2212 by 1659 pixels; 45° field of view — 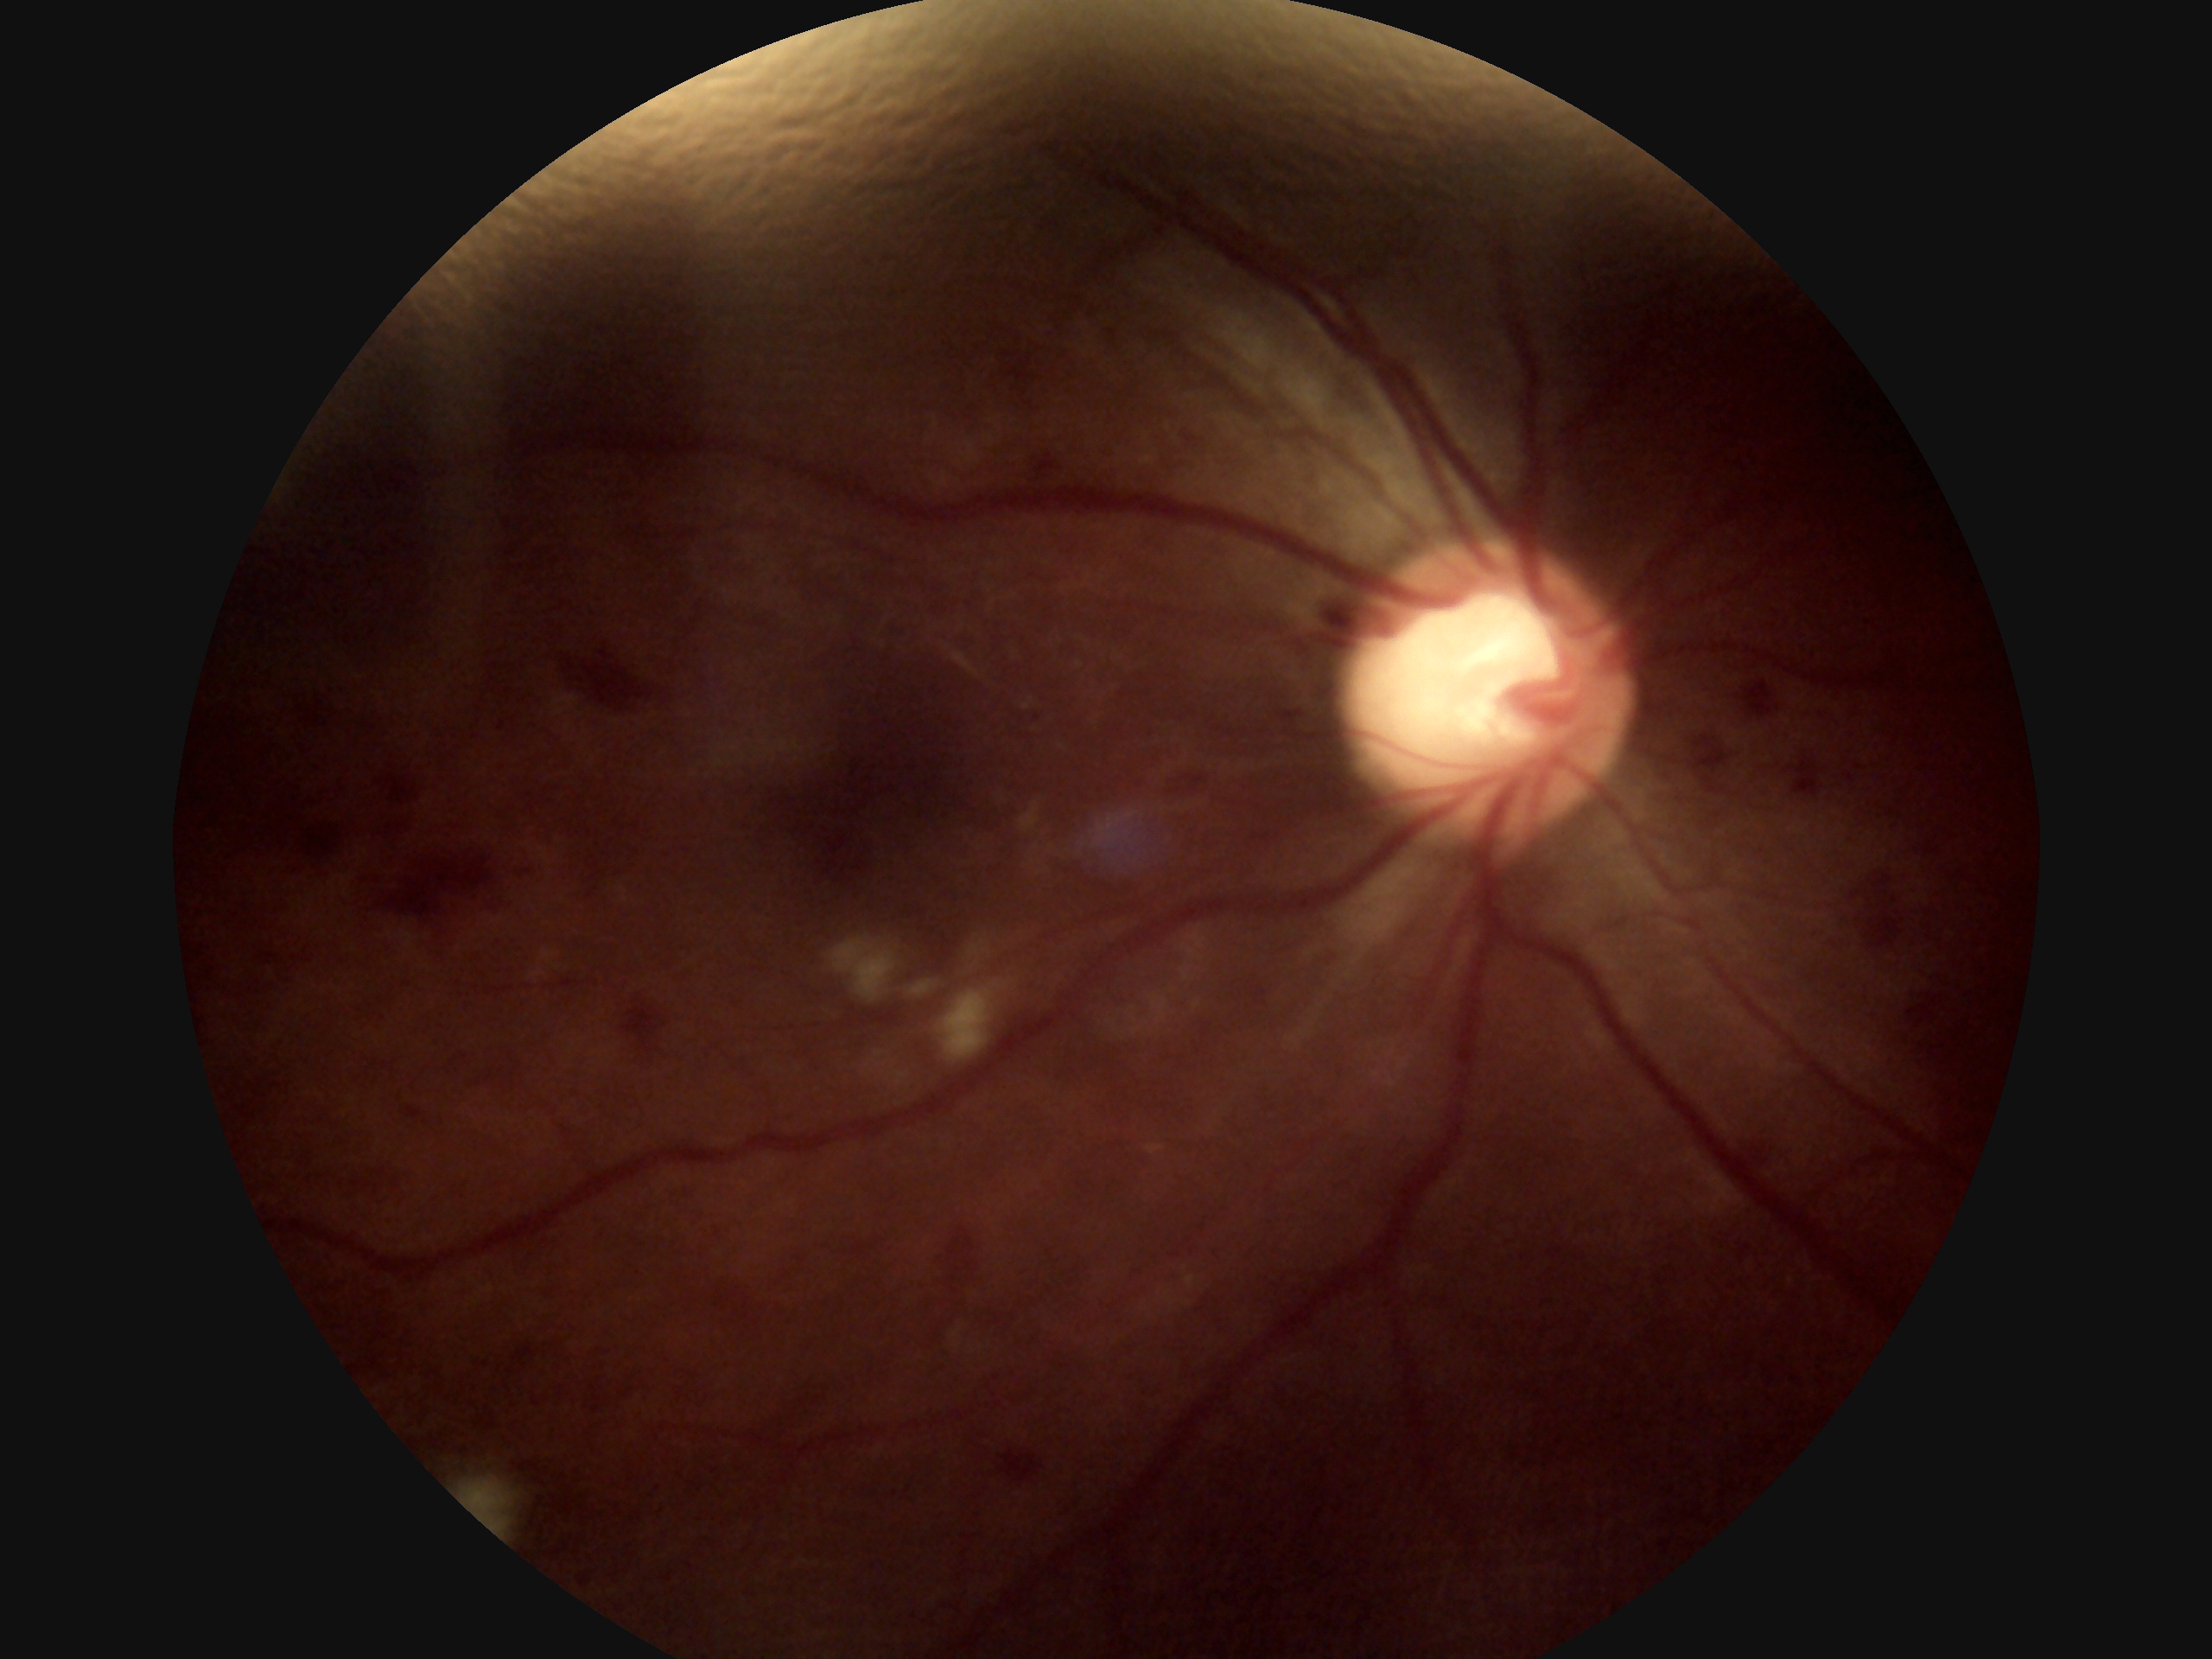

DR severity is grade 2 (moderate NPDR).